Infant wide-field fundus photograph. 1440 by 1080 pixels: 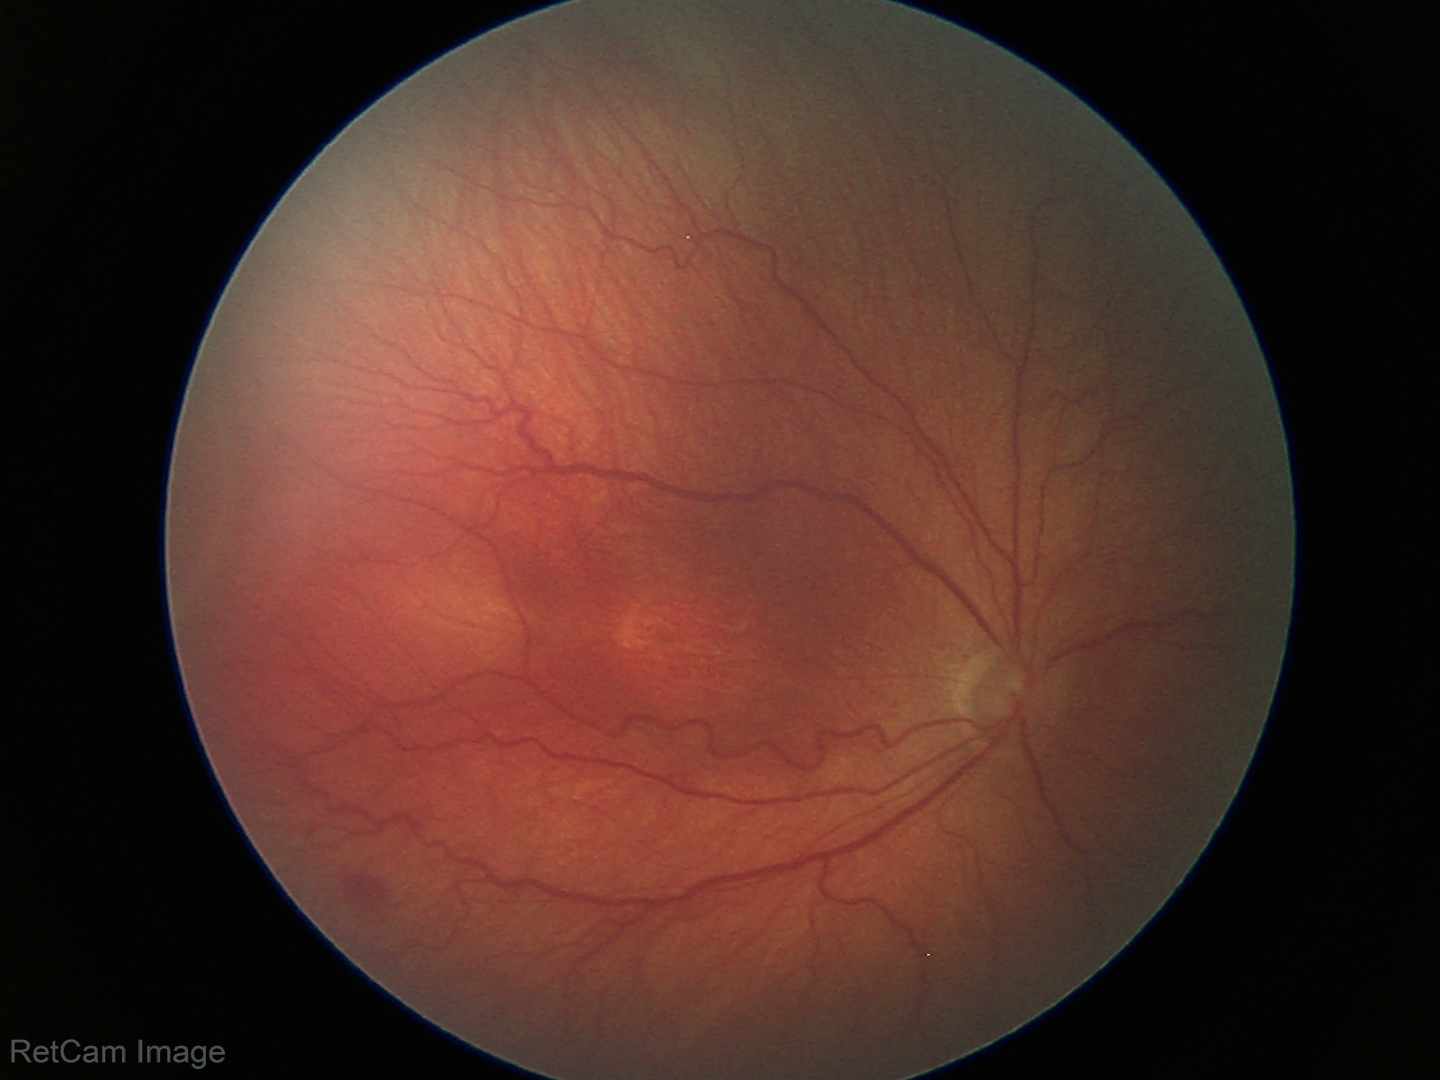 Without plus disease.
Series diagnosed as ROP stage 3.